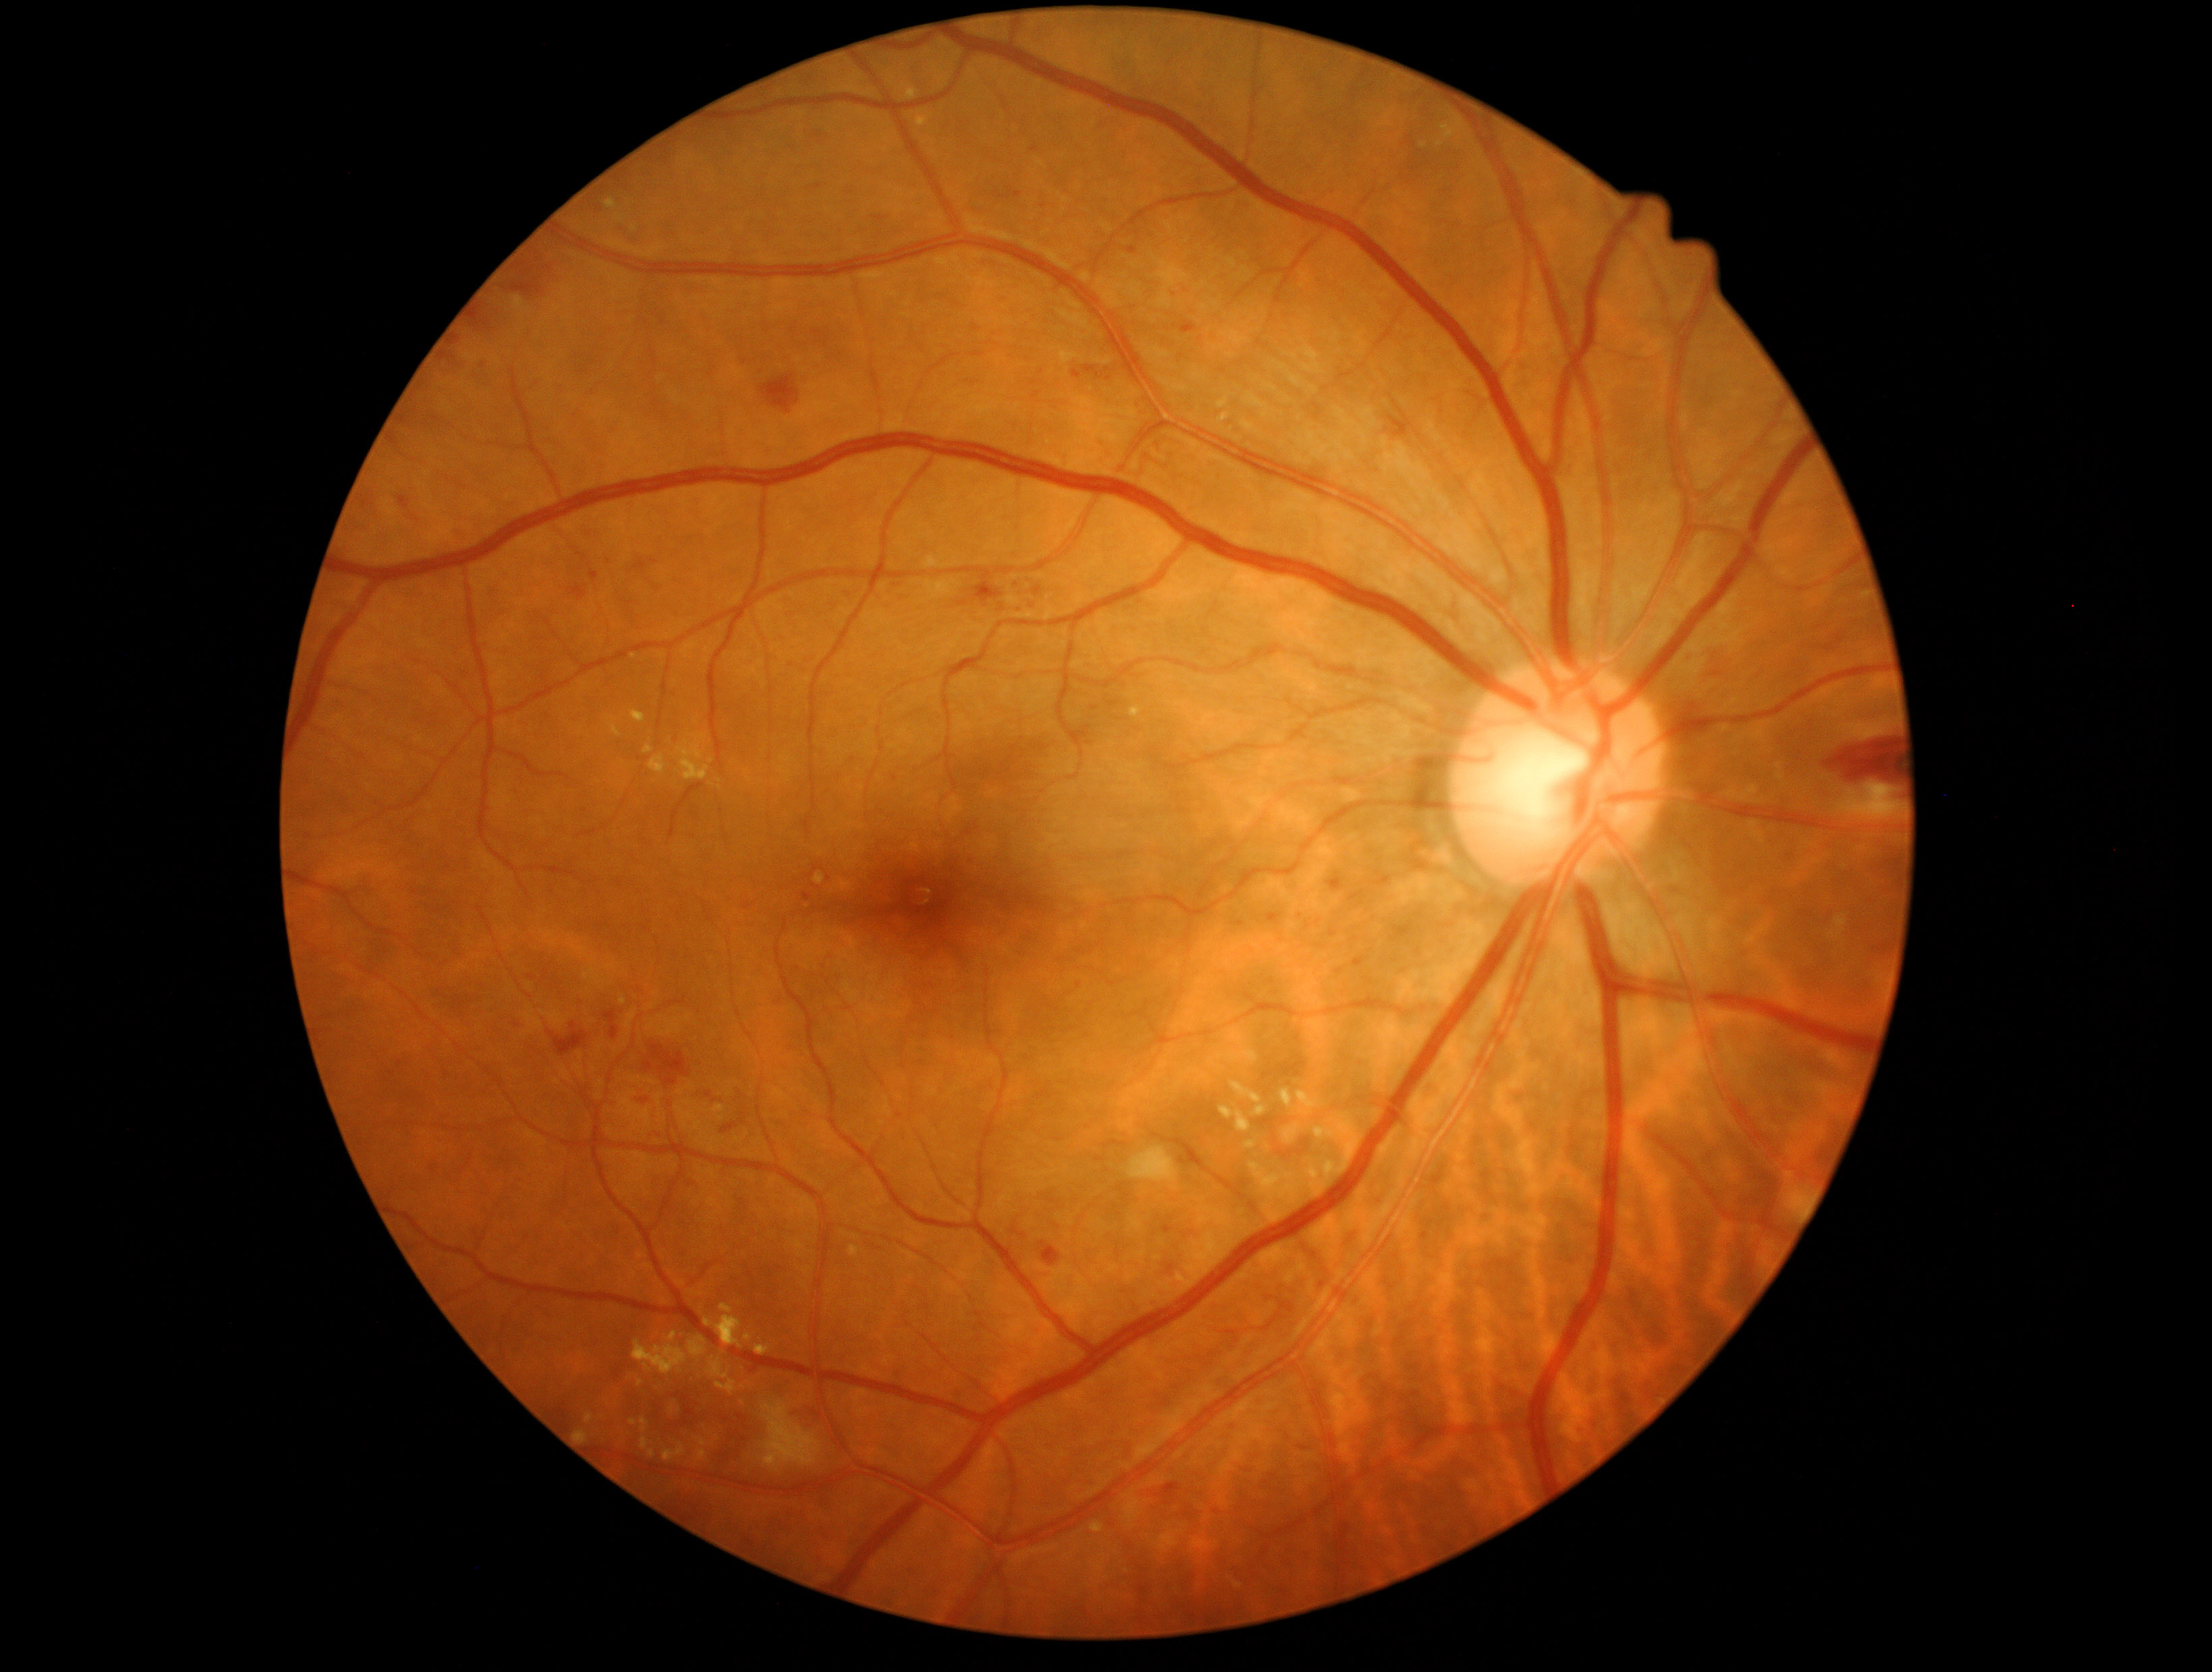
DR grade: 2 (moderate NPDR)
A subset of detected lesions:
* EXs (more not shown): {"x1": 1229, "y1": 1081, "x2": 1262, "y2": 1104} | {"x1": 1328, "y1": 1163, "x2": 1335, "y2": 1182} | {"x1": 815, "y1": 873, "x2": 825, "y2": 885} | {"x1": 586, "y1": 1414, "x2": 593, "y2": 1423} | {"x1": 649, "y1": 753, "x2": 667, "y2": 775} | {"x1": 697, "y1": 1449, "x2": 707, "y2": 1460} | {"x1": 1281, "y1": 1089, "x2": 1294, "y2": 1108} | {"x1": 632, "y1": 710, "x2": 645, "y2": 723} | {"x1": 644, "y1": 744, "x2": 653, "y2": 753} | {"x1": 755, "y1": 1342, "x2": 771, "y2": 1356} | {"x1": 713, "y1": 1105, "x2": 726, "y2": 1113} | {"x1": 1090, "y1": 1522, "x2": 1105, "y2": 1531} | {"x1": 676, "y1": 736, "x2": 710, "y2": 781} | {"x1": 707, "y1": 1357, "x2": 729, "y2": 1379}
* Small EXs approximately at pt(641, 1382) | pt(719, 781) | pt(624, 1001)
* HEs (more not shown): {"x1": 1181, "y1": 323, "x2": 1198, "y2": 334} | {"x1": 651, "y1": 1044, "x2": 689, "y2": 1085} | {"x1": 469, "y1": 307, "x2": 488, "y2": 328} | {"x1": 548, "y1": 1021, "x2": 589, "y2": 1055} | {"x1": 512, "y1": 280, "x2": 543, "y2": 299} | {"x1": 604, "y1": 1009, "x2": 621, "y2": 1039} | {"x1": 451, "y1": 335, "x2": 461, "y2": 346} | {"x1": 1082, "y1": 365, "x2": 1097, "y2": 373} | {"x1": 790, "y1": 1403, "x2": 825, "y2": 1429} | {"x1": 1329, "y1": 873, "x2": 1343, "y2": 891} | {"x1": 711, "y1": 1096, "x2": 725, "y2": 1104} | {"x1": 1157, "y1": 1483, "x2": 1178, "y2": 1492} | {"x1": 1032, "y1": 586, "x2": 1043, "y2": 595}
* Small HEs approximately at pt(518, 1024)